CFP; 45-degree field of view; image size 2212x1659.
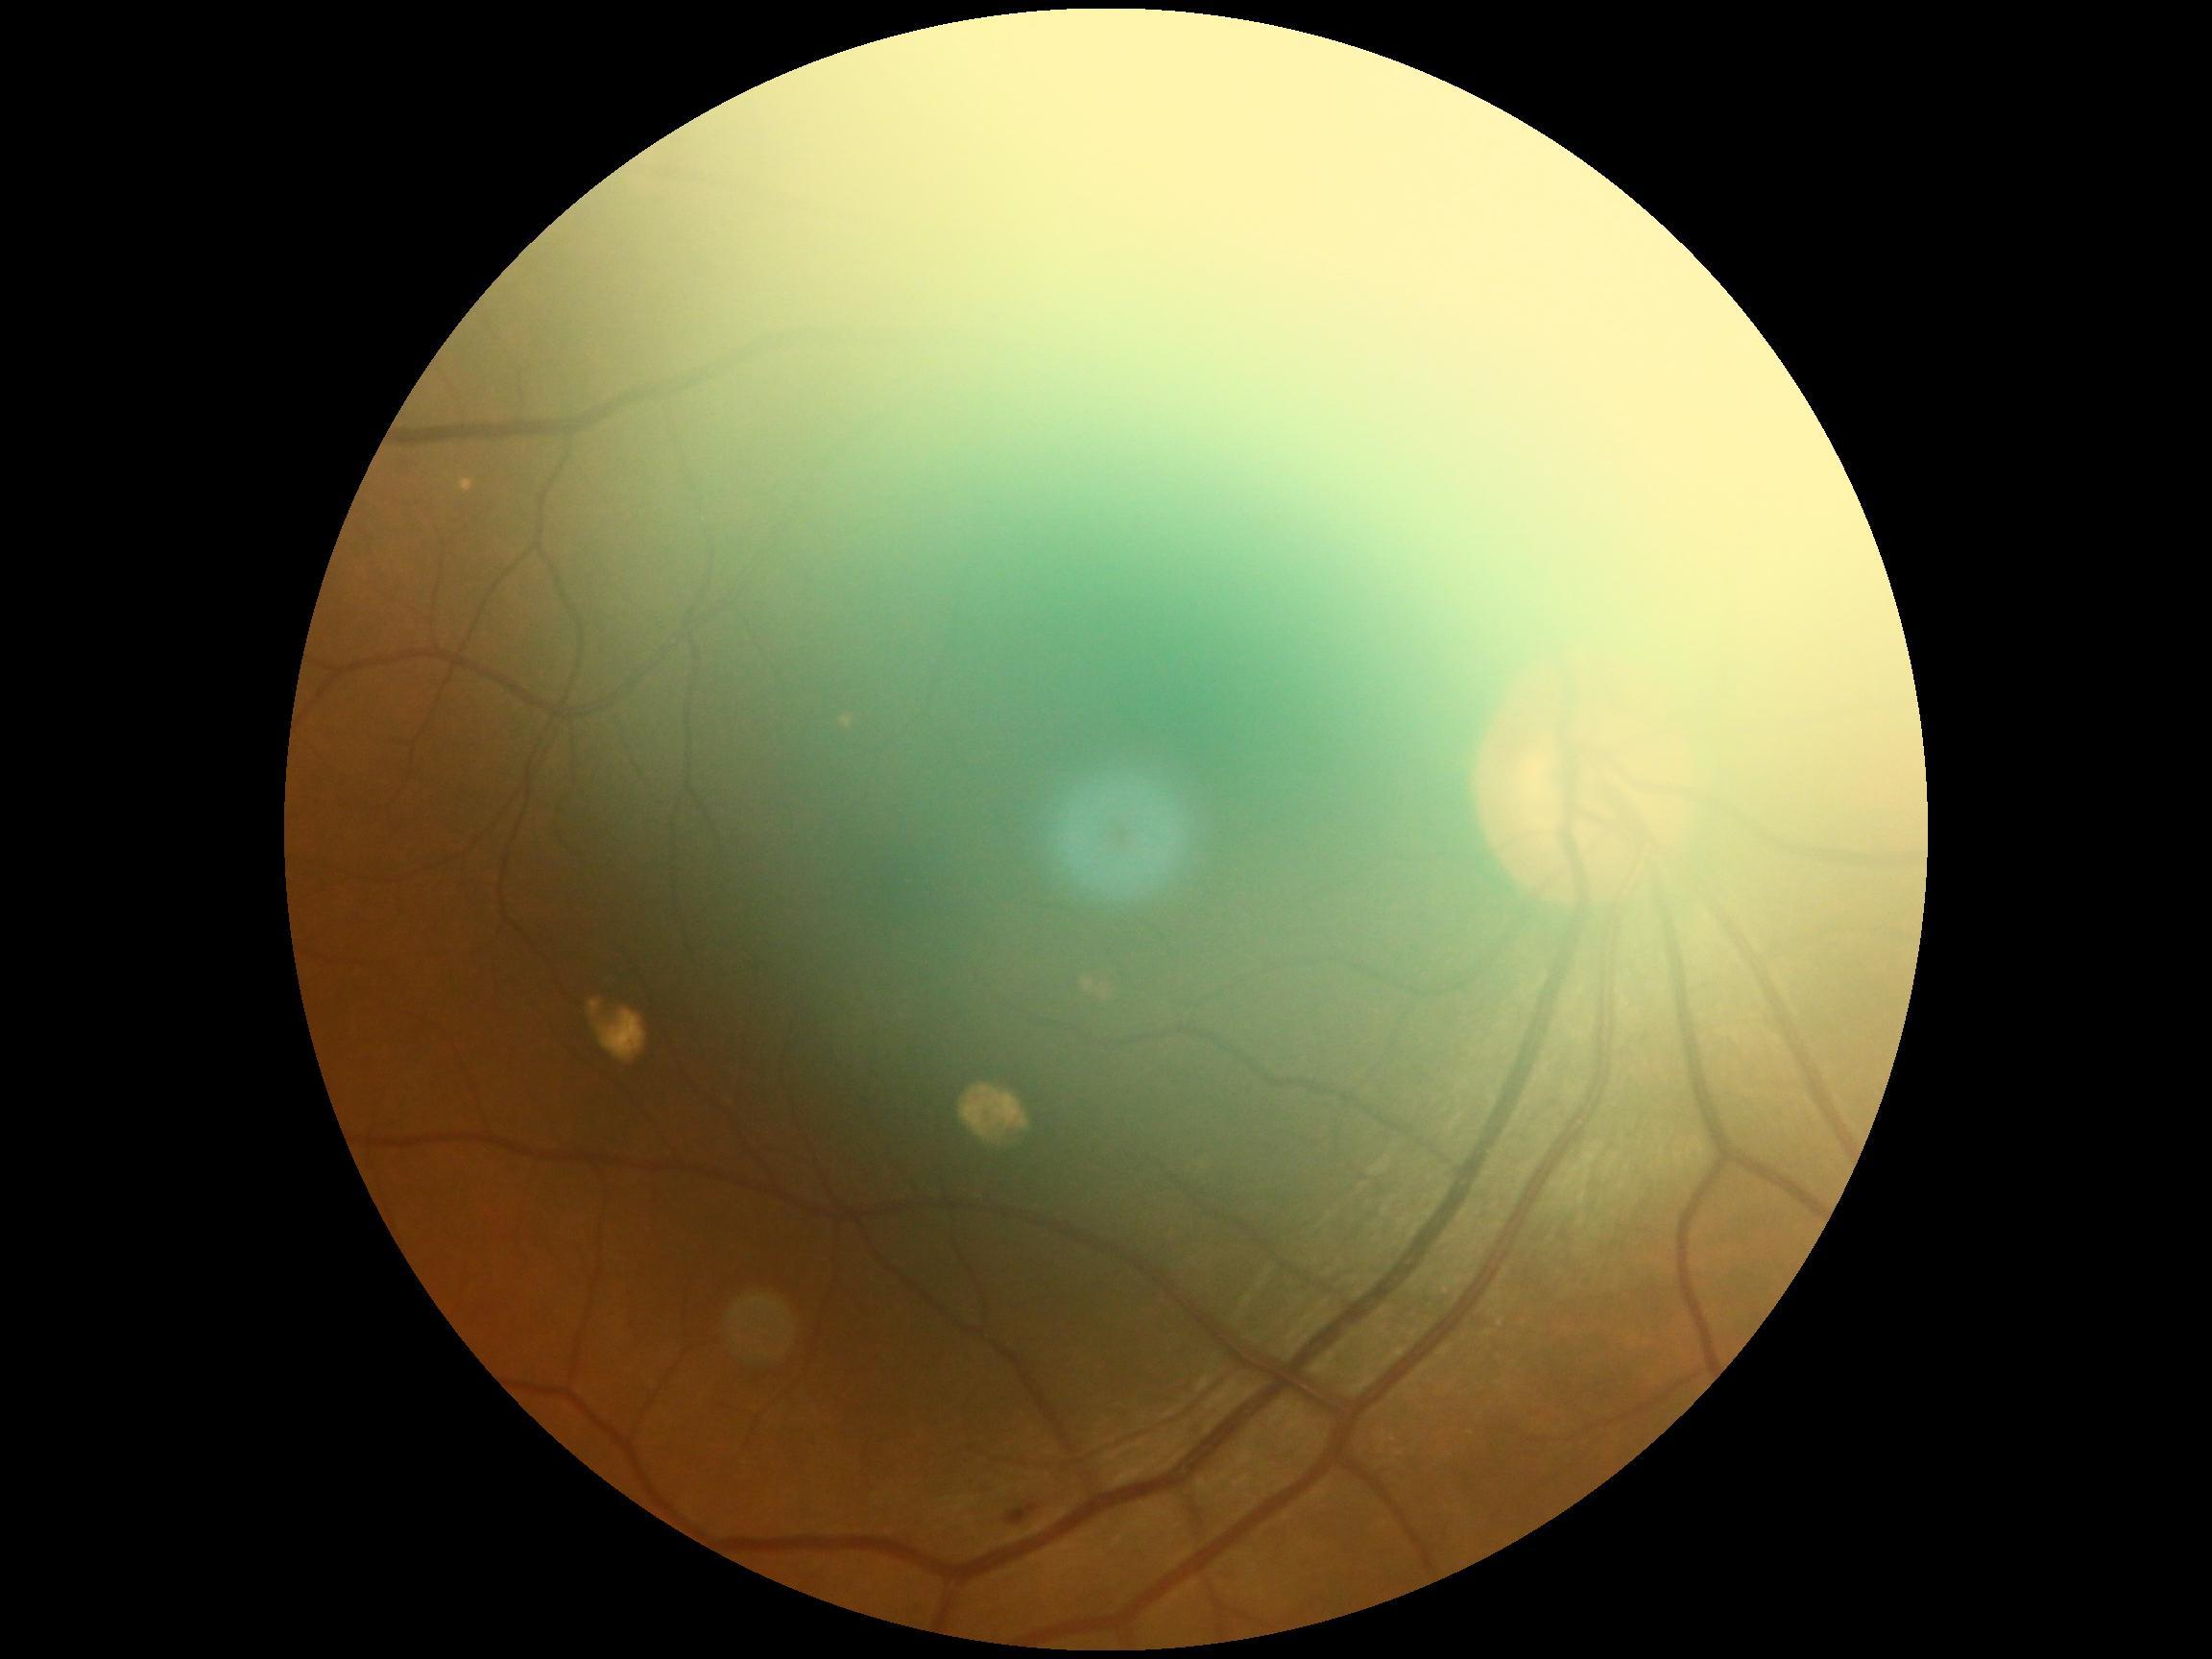
Diabetic retinopathy severity is grade 2 (moderate NPDR) — more than just microaneurysms but less than severe NPDR.